Fundus photo — 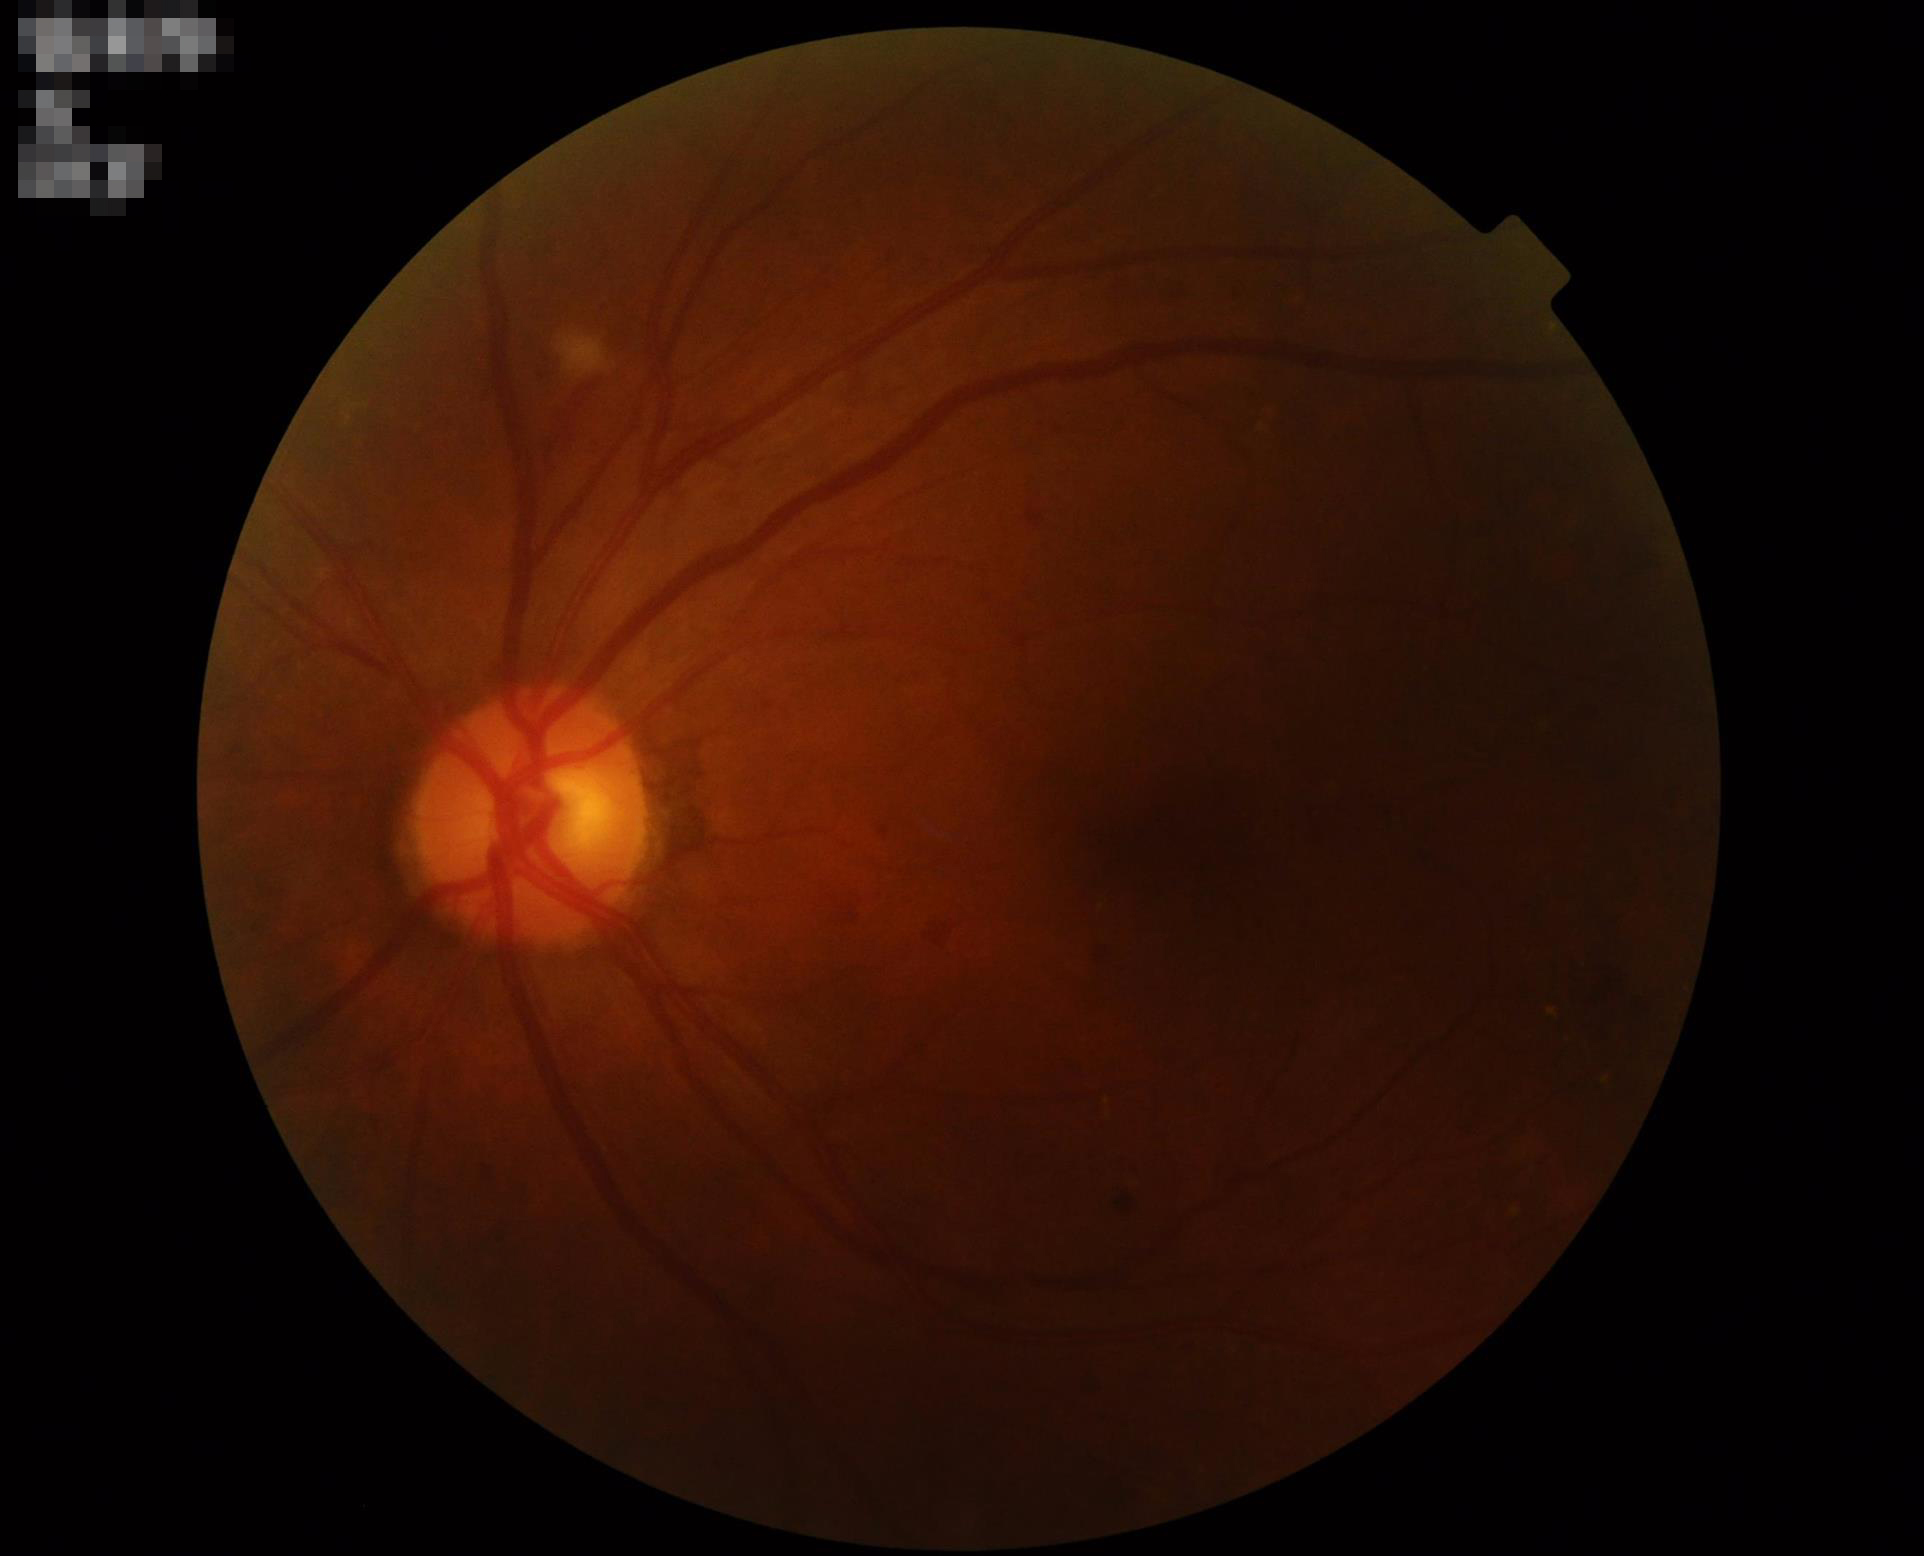

  clarity: in focus
  illumination: suboptimal
  overall_quality: low
  contrast: adequate